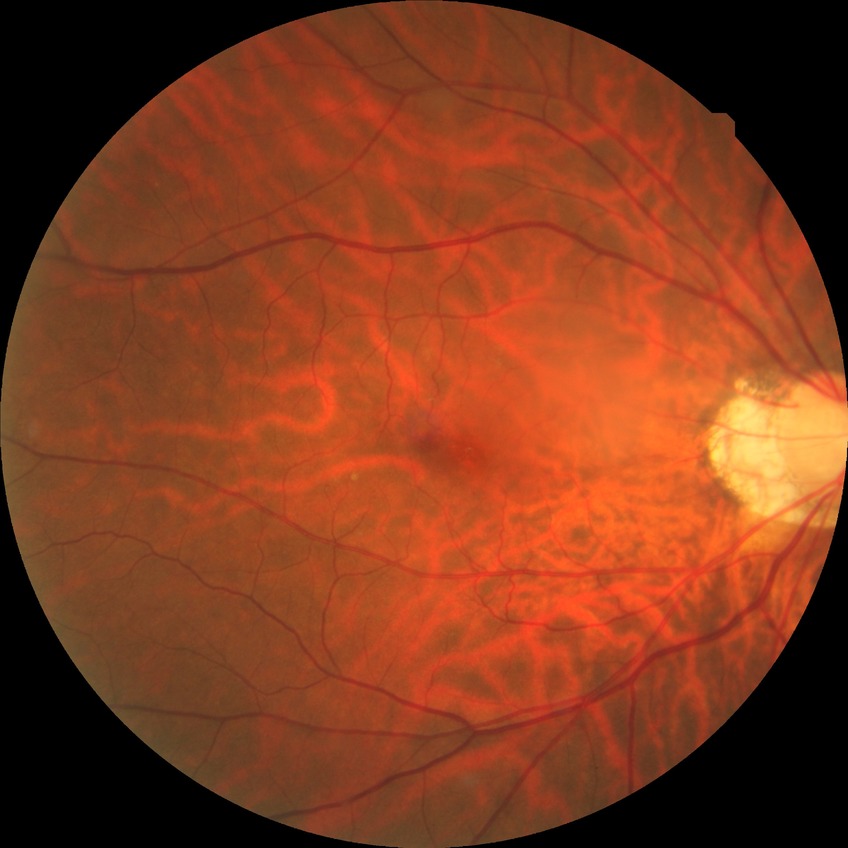

Davis grade@NDR, DR impression@no DR findings.